Ultra-widefield fundus photograph — 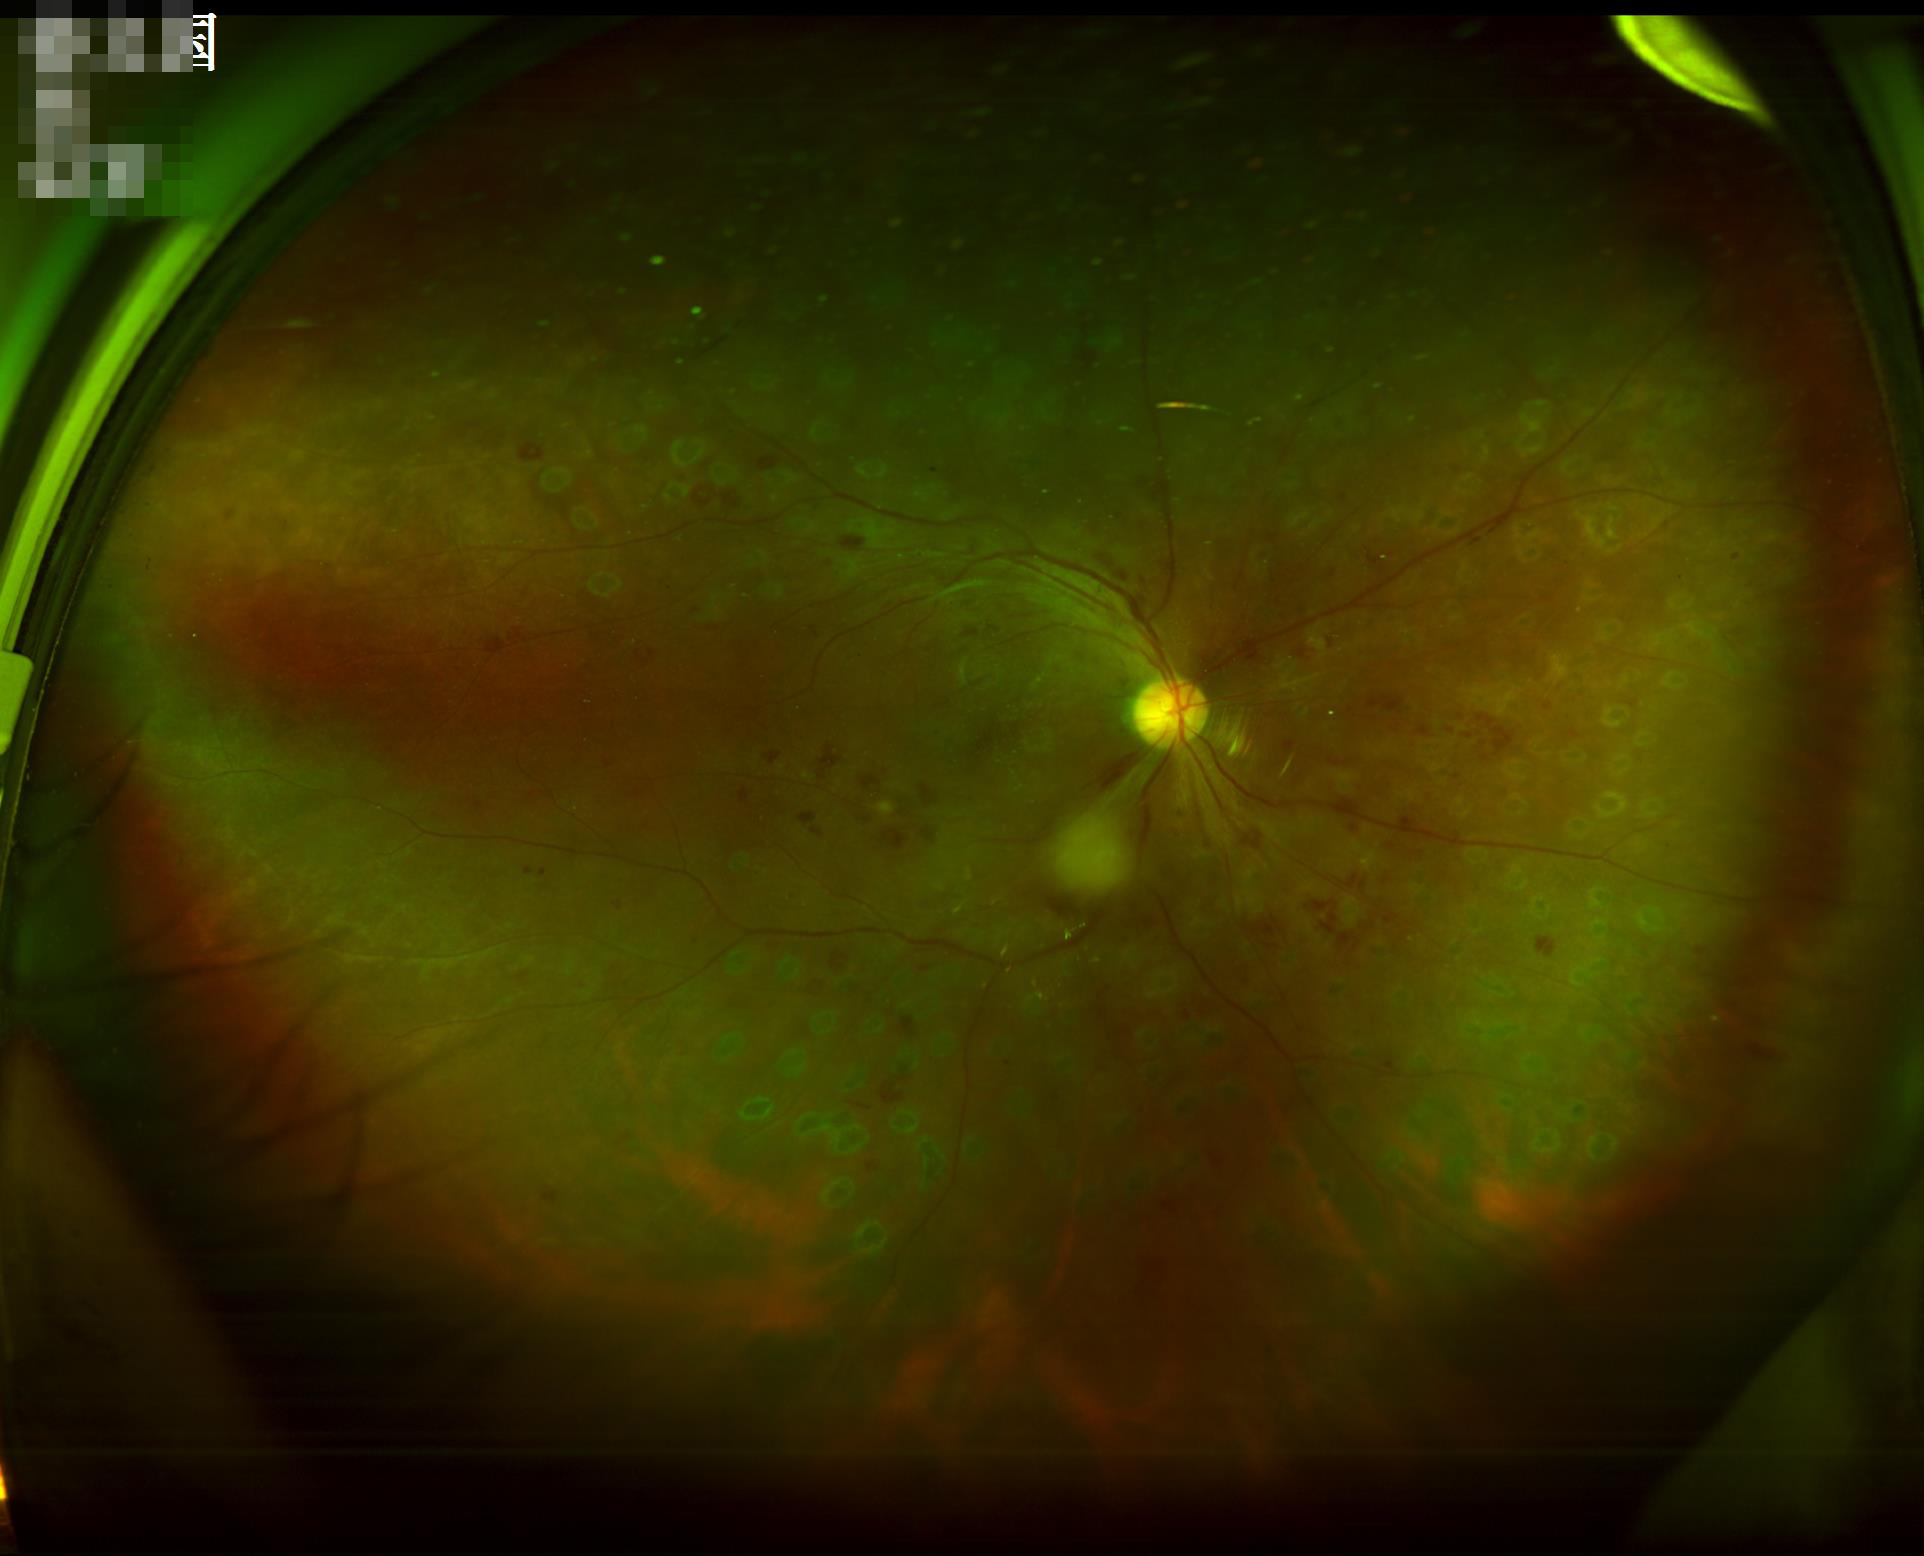 Illumination: good illumination and color balance; Overall: good and suitable for diagnostic use; Clarity: clear with no noticeable blur.